Camera: Clarity RetCam 3 (130° FOV). Wide-field fundus image from infant ROP screening. 640x480 — 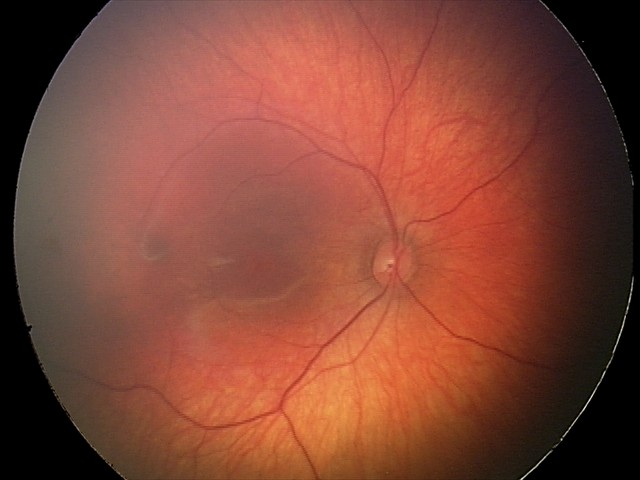 From an examination with diagnosis of retinal hemorrhages.